45-degree field of view.
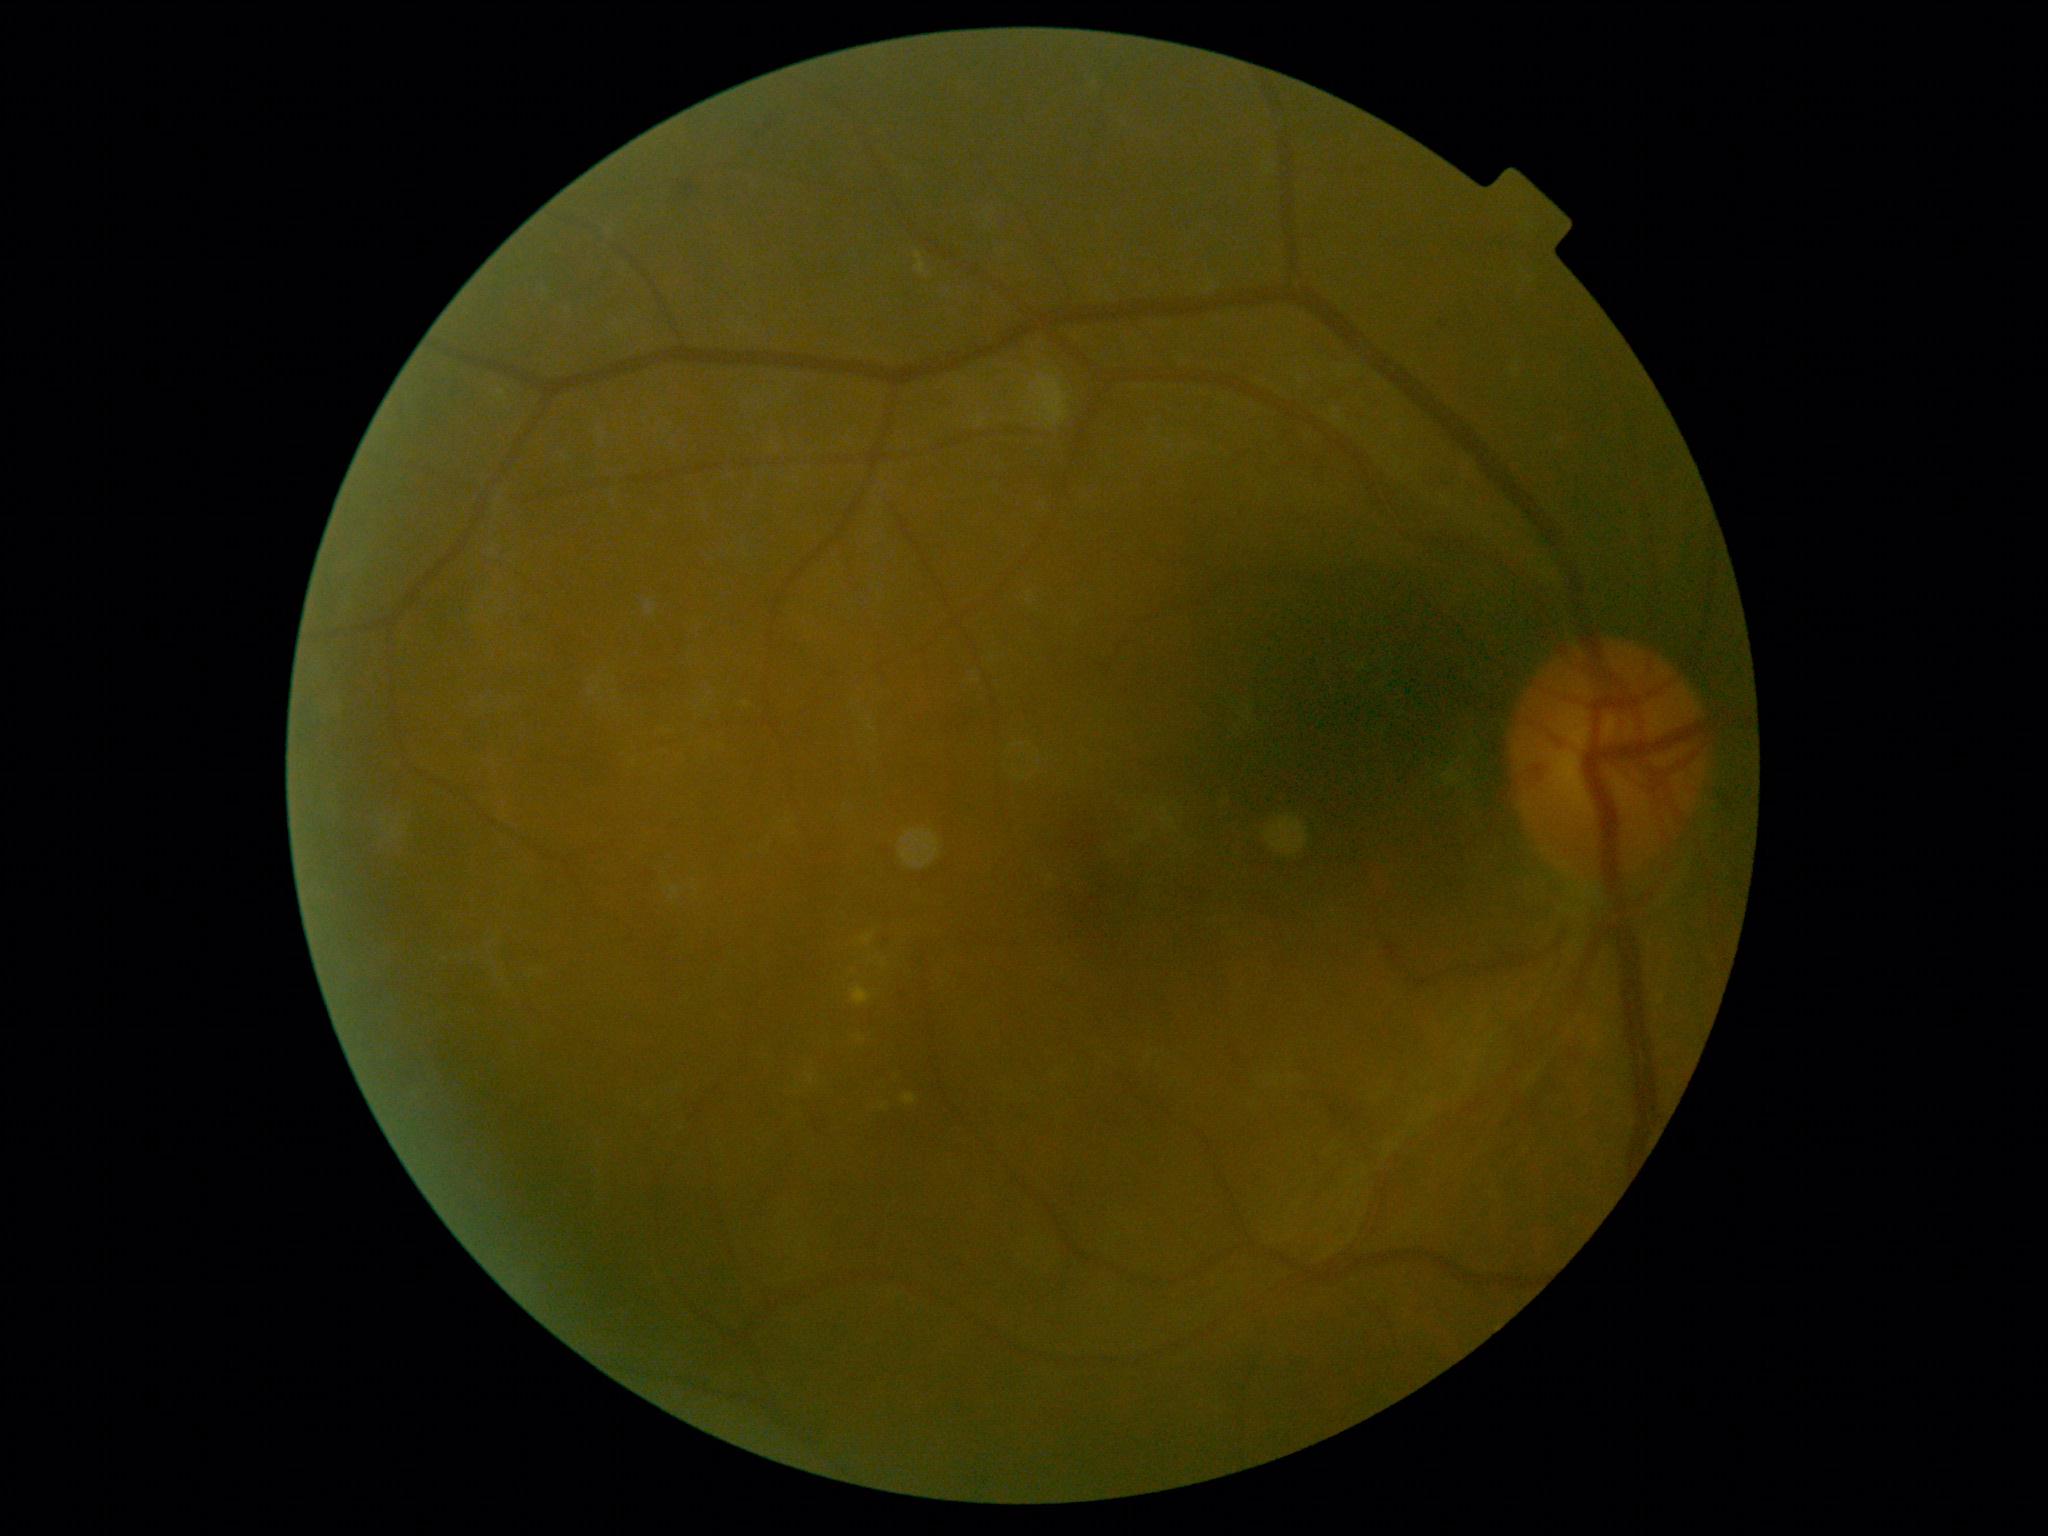 Annotations:
• diabetic retinopathy (DR): grade 2 (moderate NPDR)